Graded on the modified Davis scale — 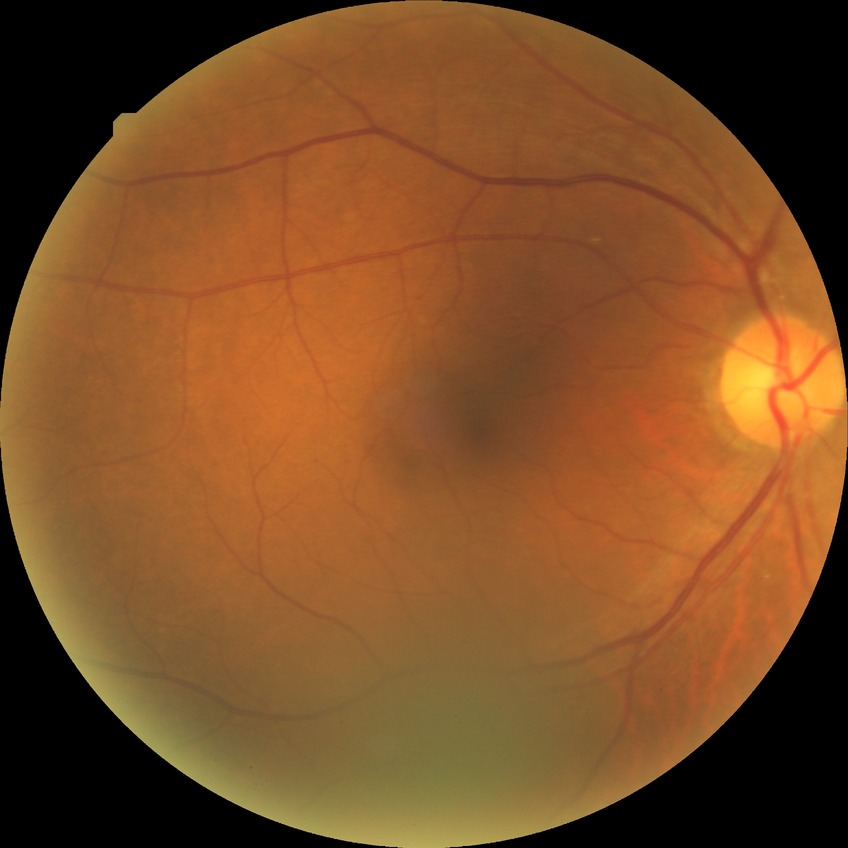

diabetic retinopathy (DR): no diabetic retinopathy (NDR).